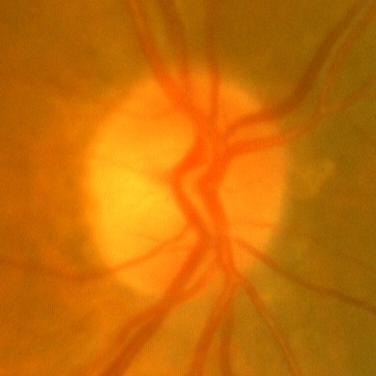
Q: Does this eye have glaucoma?
A: No — no signs of glaucoma.